Wide-field fundus photograph of an infant. Captured with the Phoenix ICON (100° field of view): 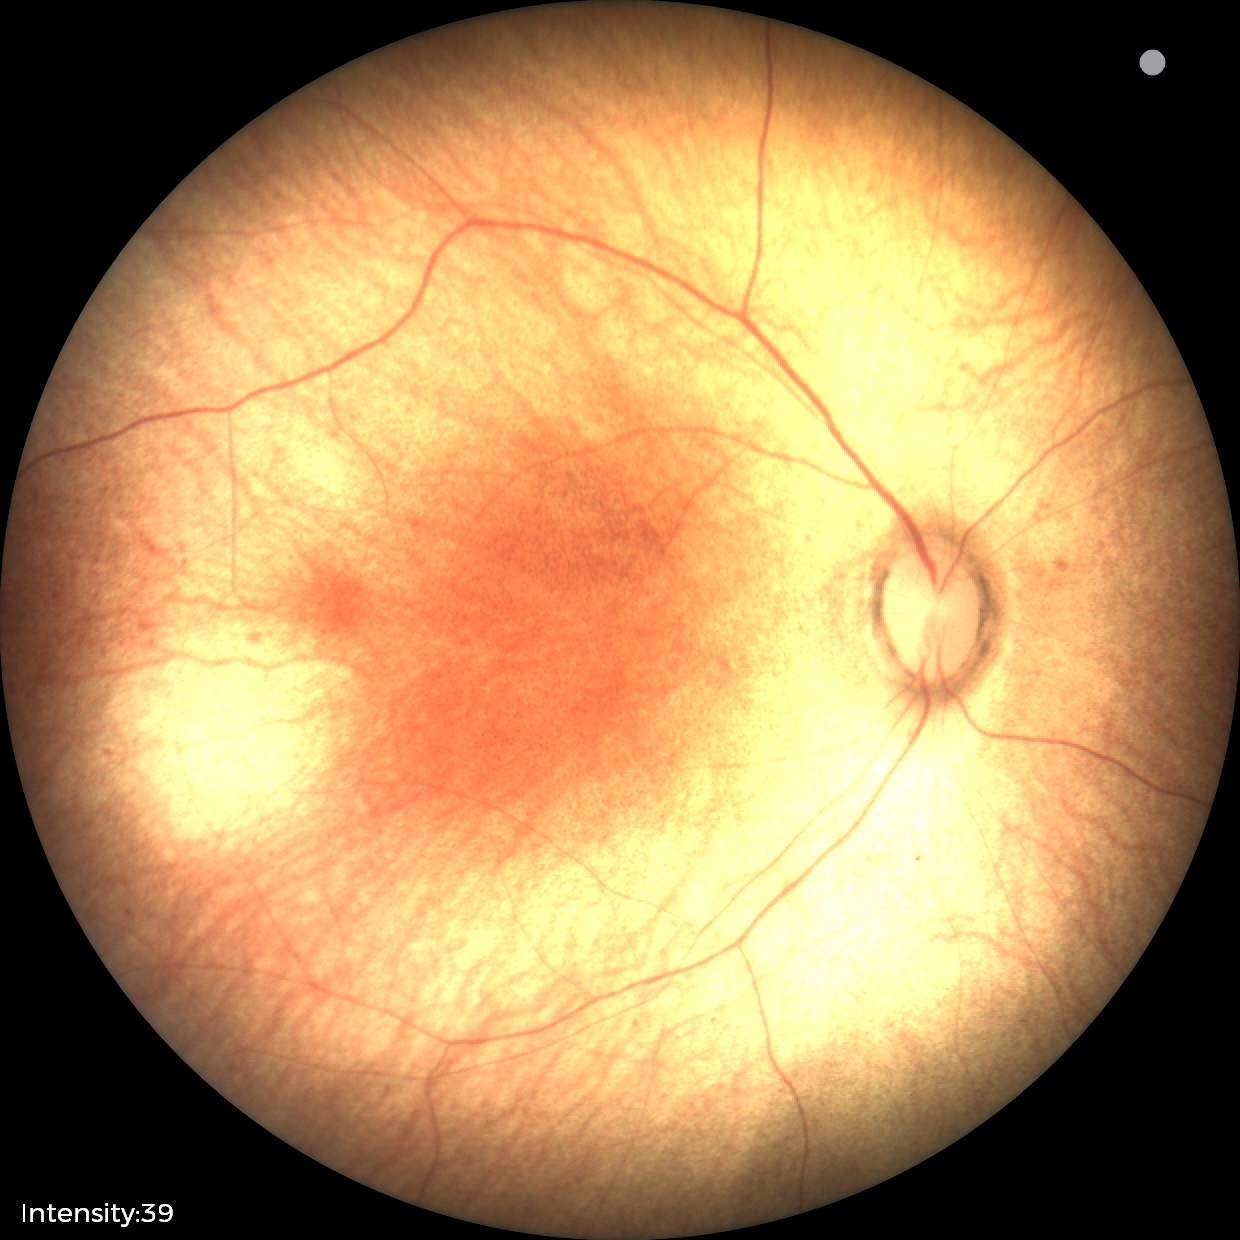
Screening examination diagnosed as physiological.